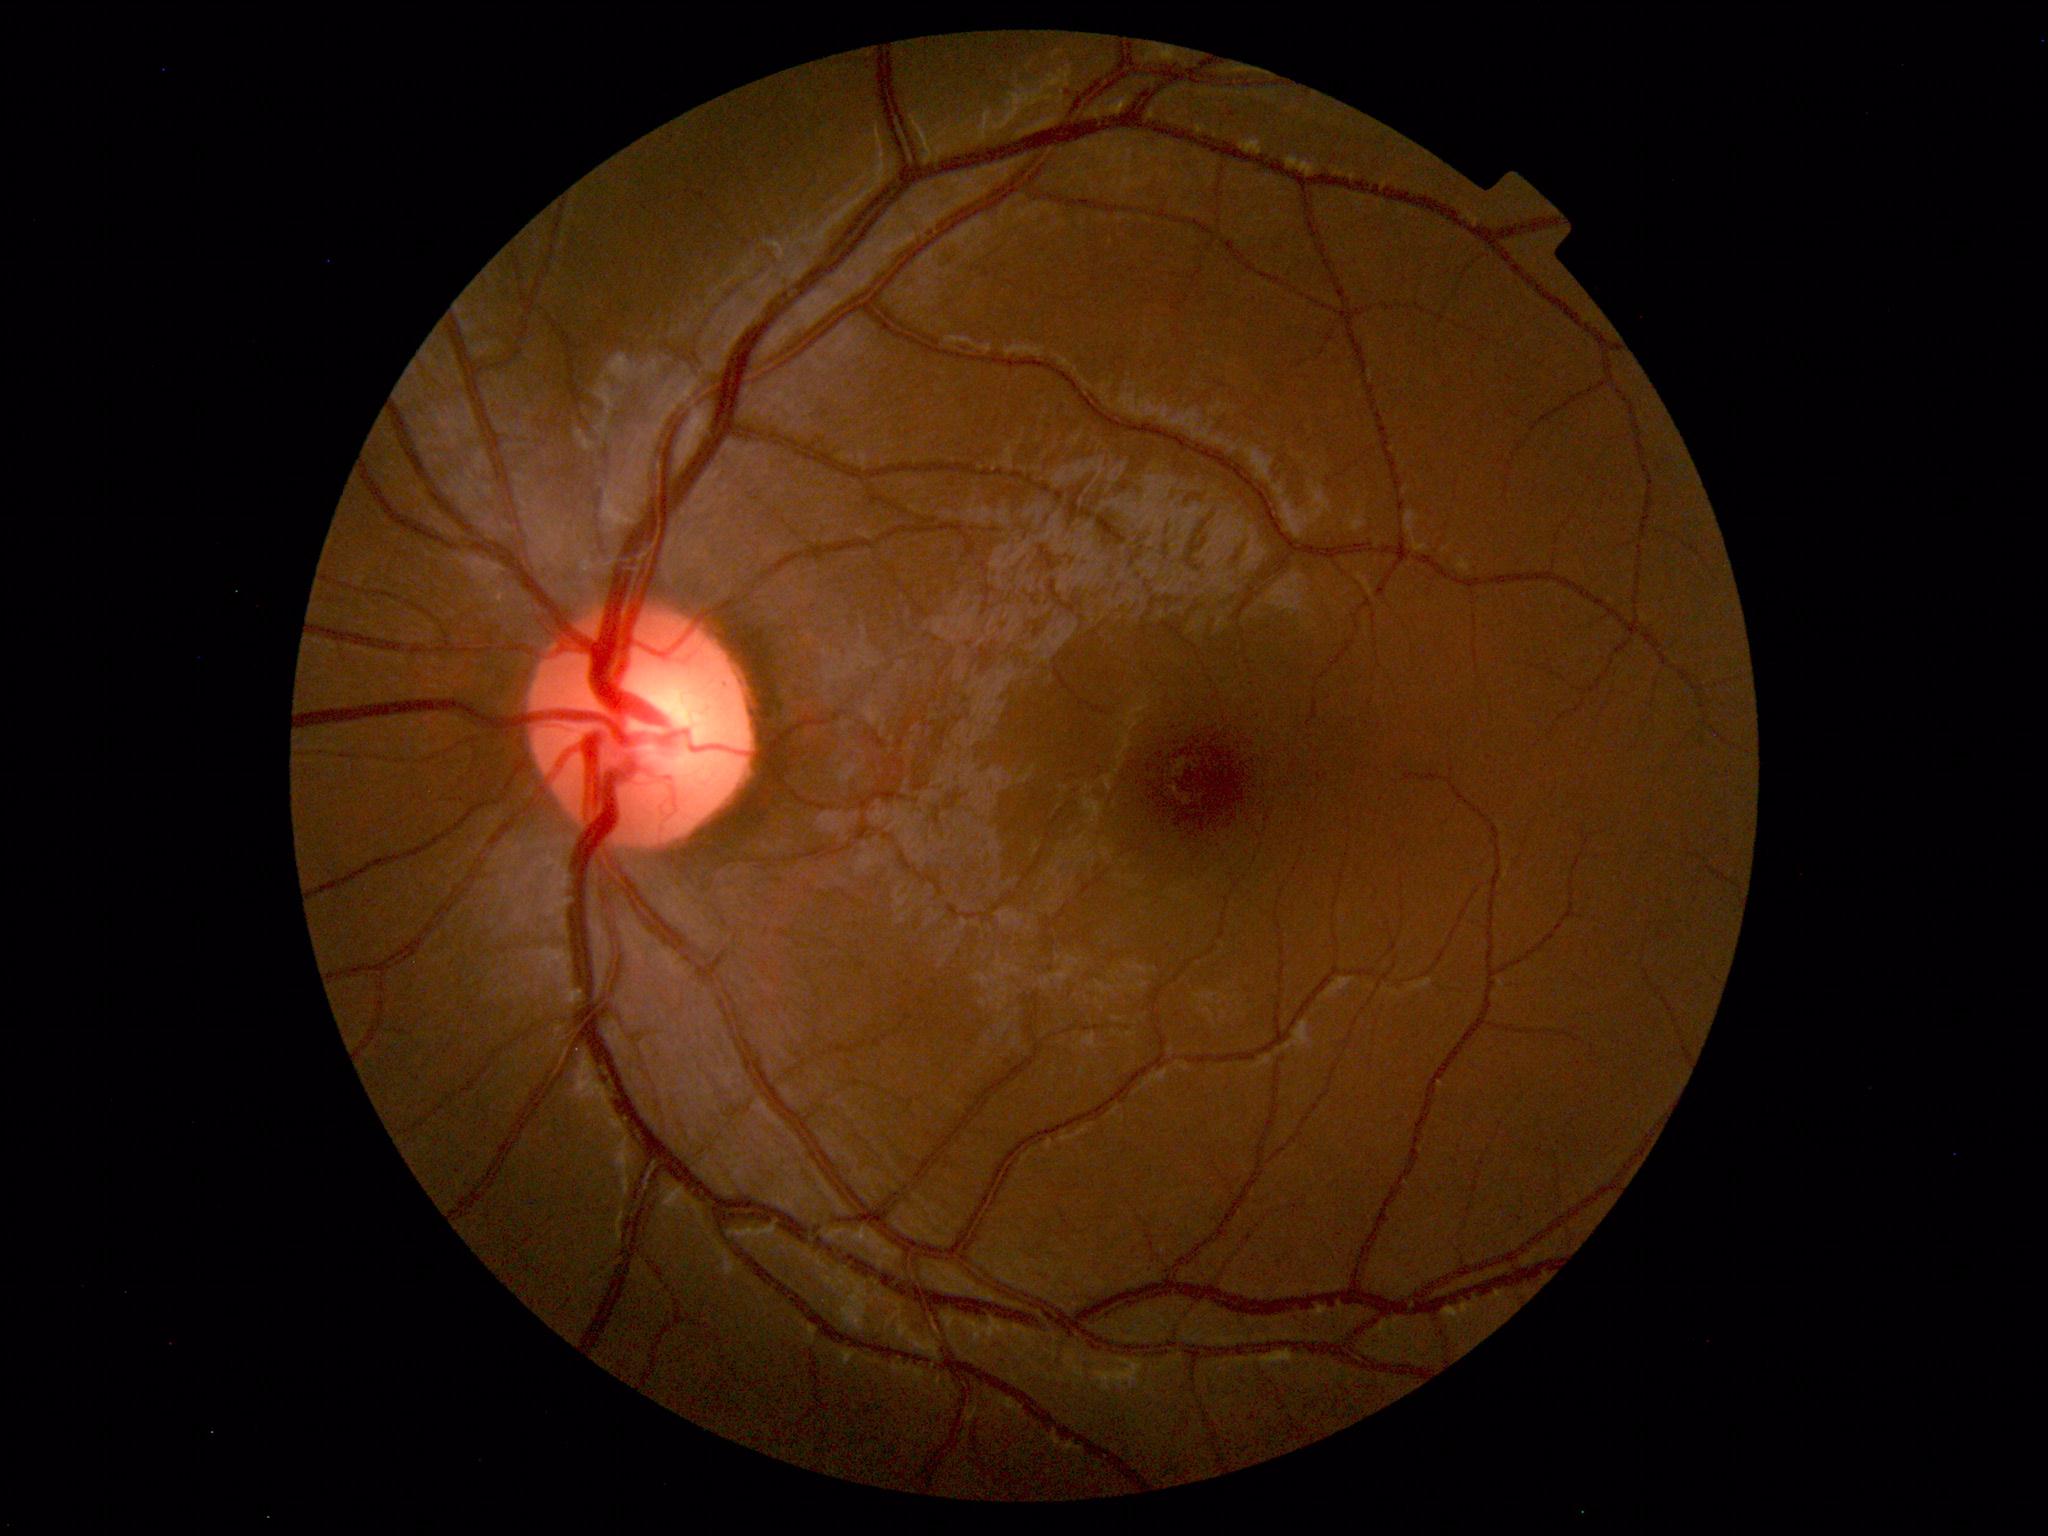 No retinal pathology identified.